Without pupil dilation; retinal fundus photograph
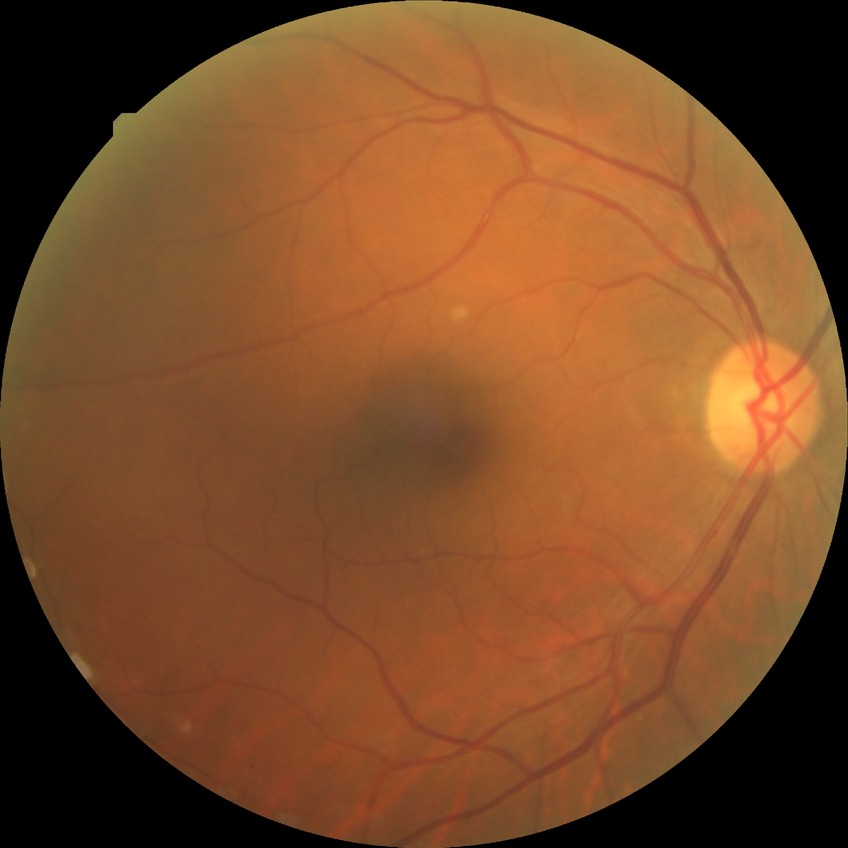
diabetic retinopathy (DR): no diabetic retinopathy (NDR).